Ultra-widefield fundus photograph.
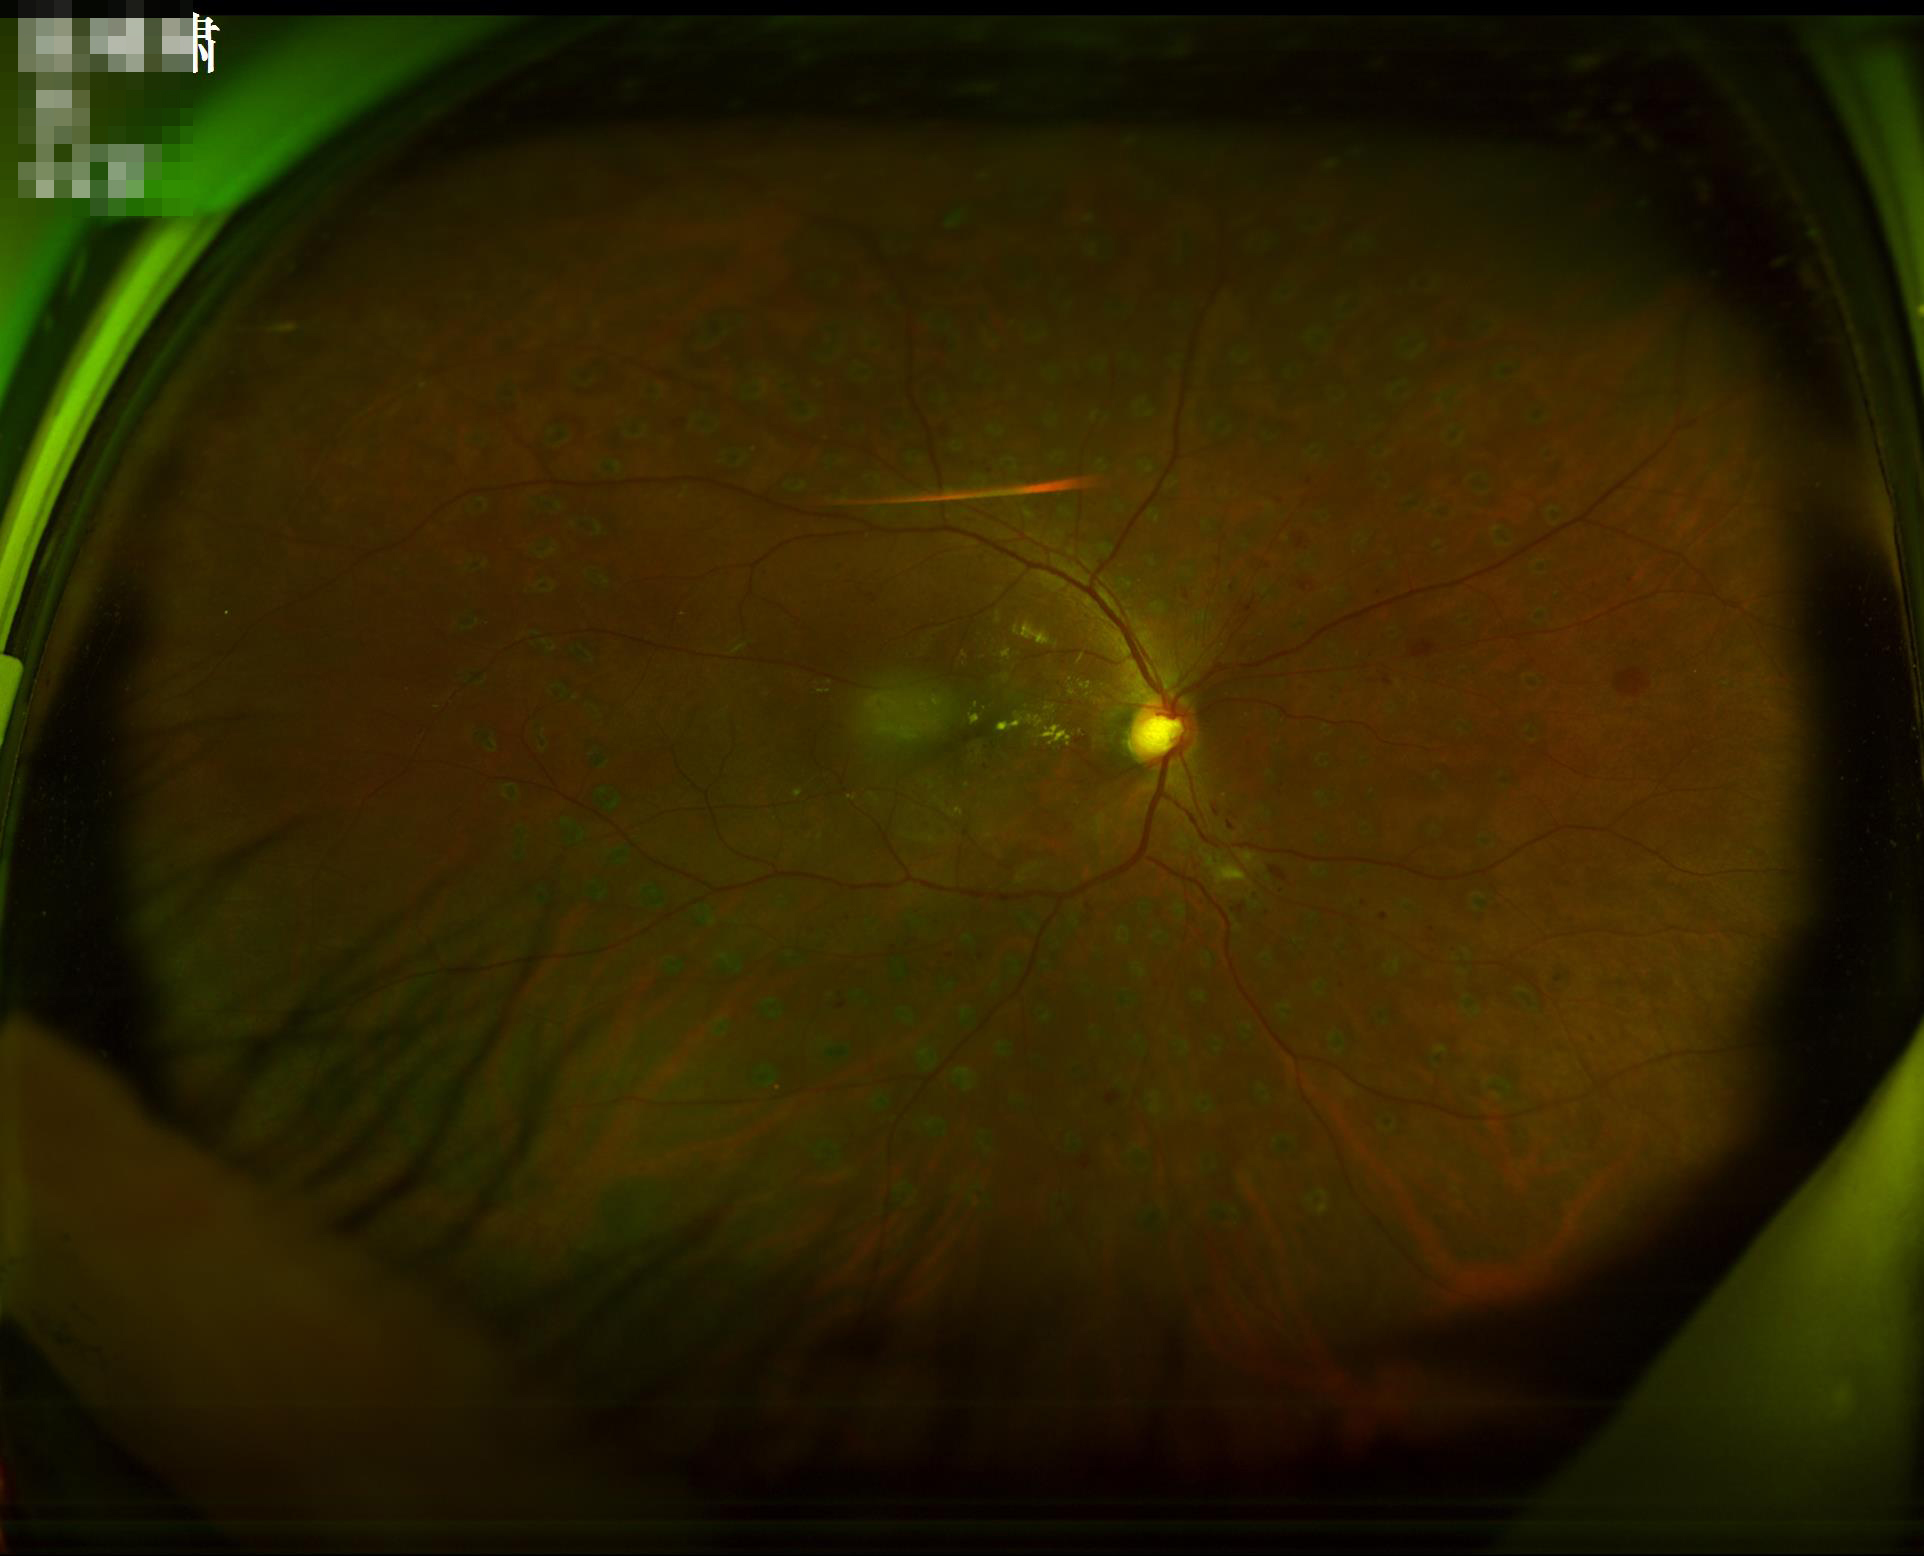 Quality grading: contrast: good dynamic range | overall: adequate for clinical interpretation.